Infant wide-field retinal image
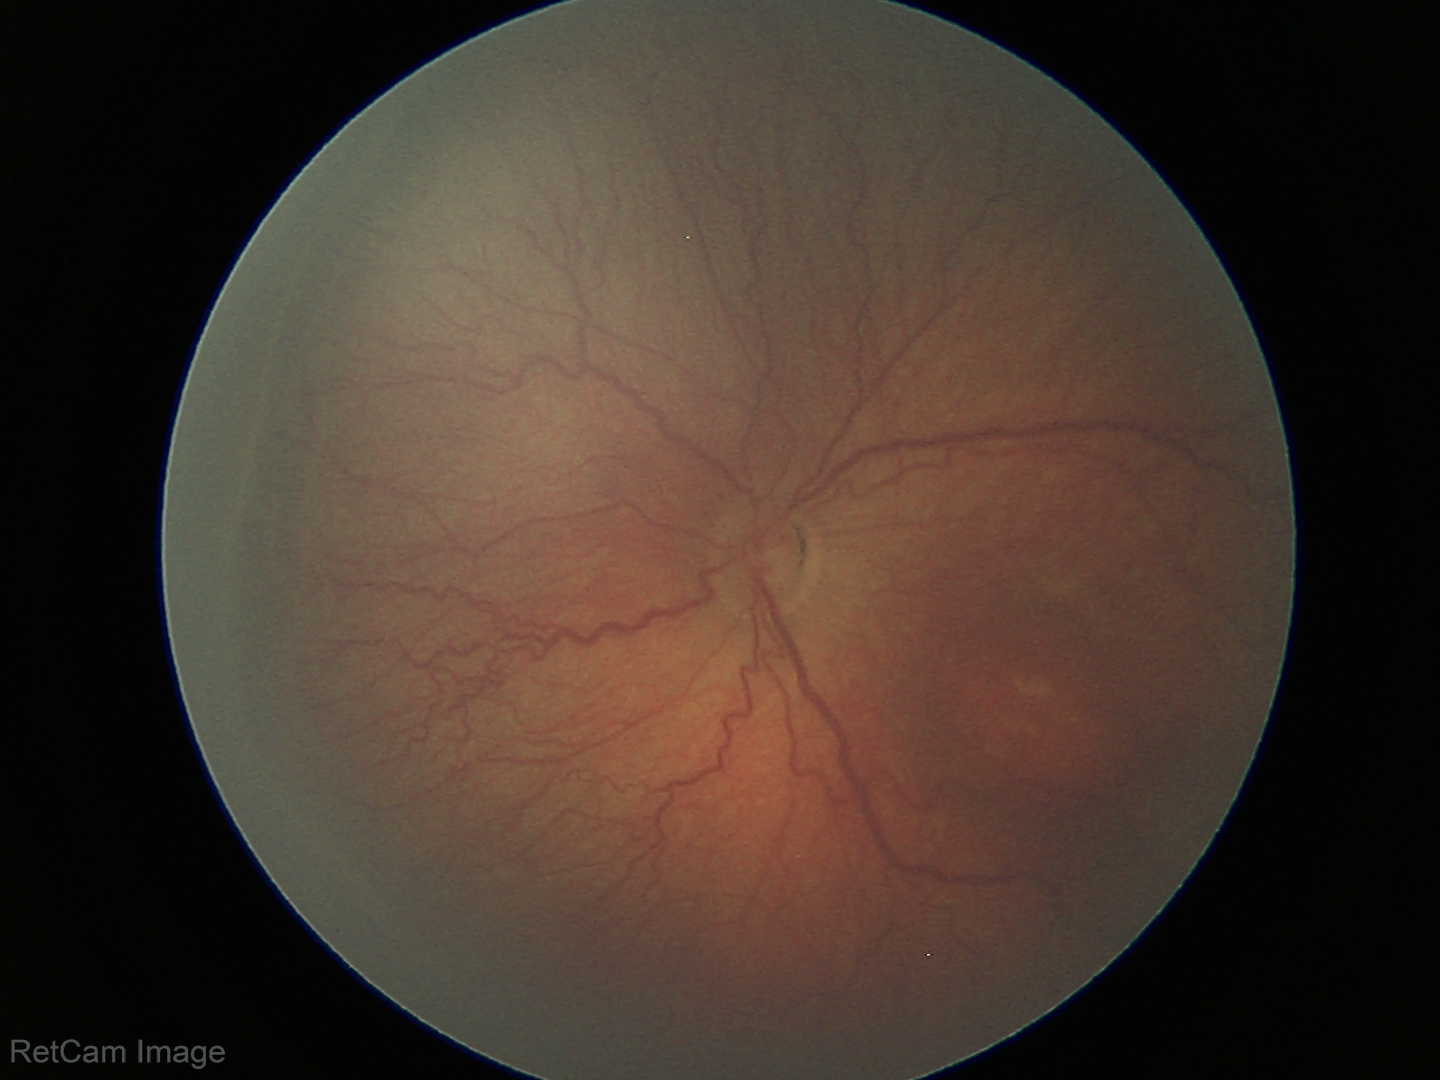
Plus disease absent.
From an examination with diagnosis of ROP stage 3.